45° field of view, nonmydriatic fundus photograph, acquired with a NIDEK AFC-230, 848 x 848 pixels — 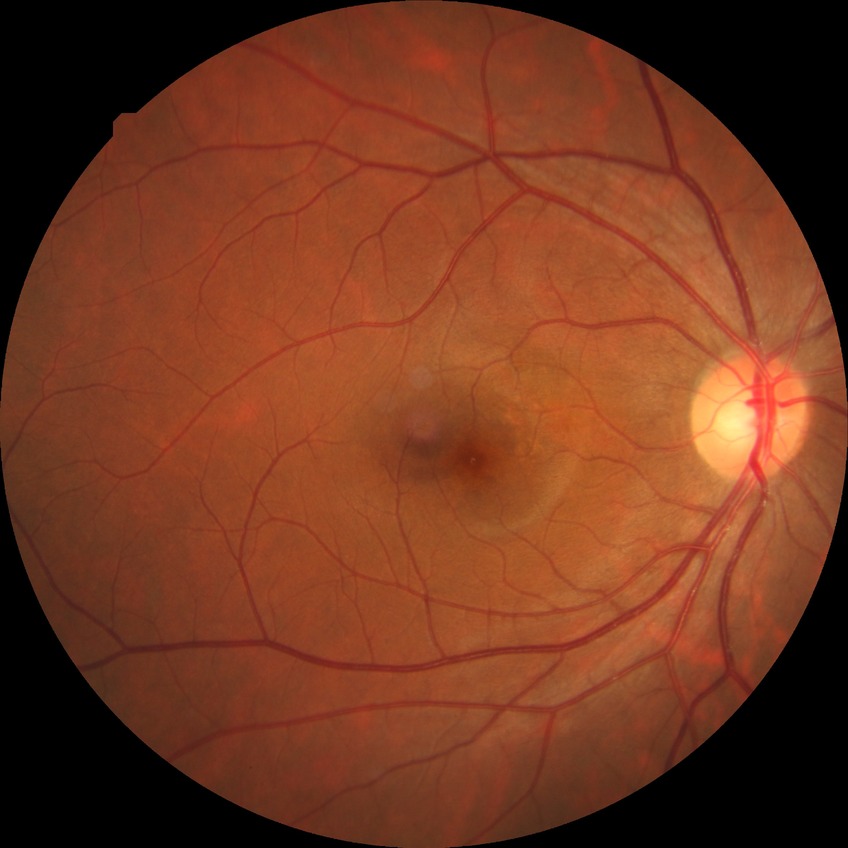

Diabetic retinopathy (DR) is NDR (no diabetic retinopathy).